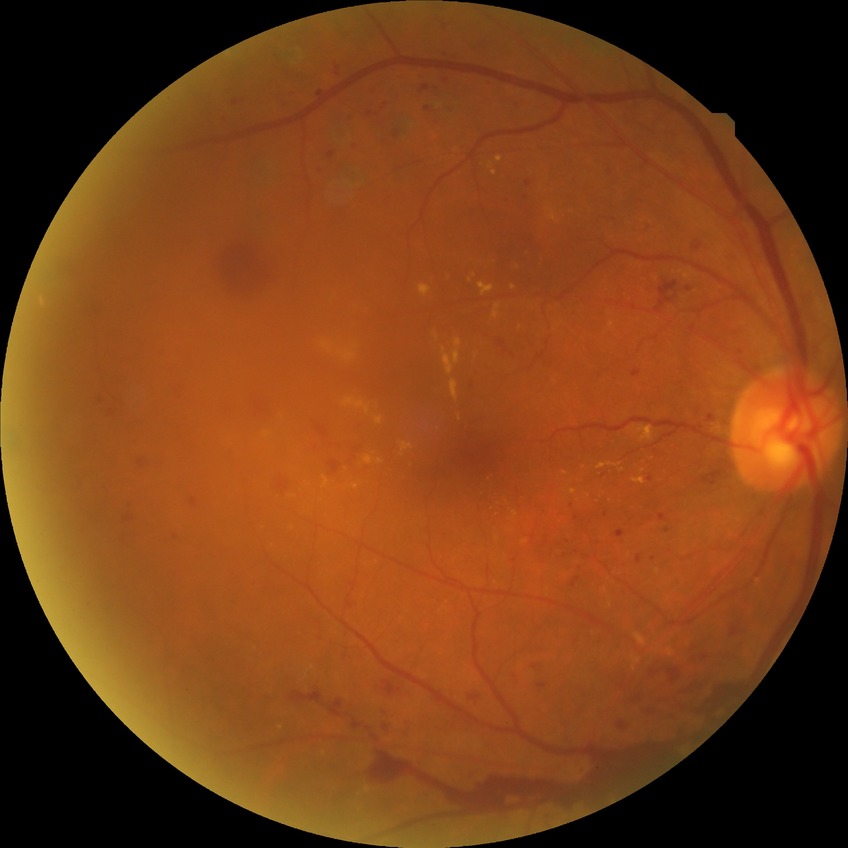 Diabetic retinopathy (DR) is PDR (proliferative diabetic retinopathy).